2352 x 1568 pixels.
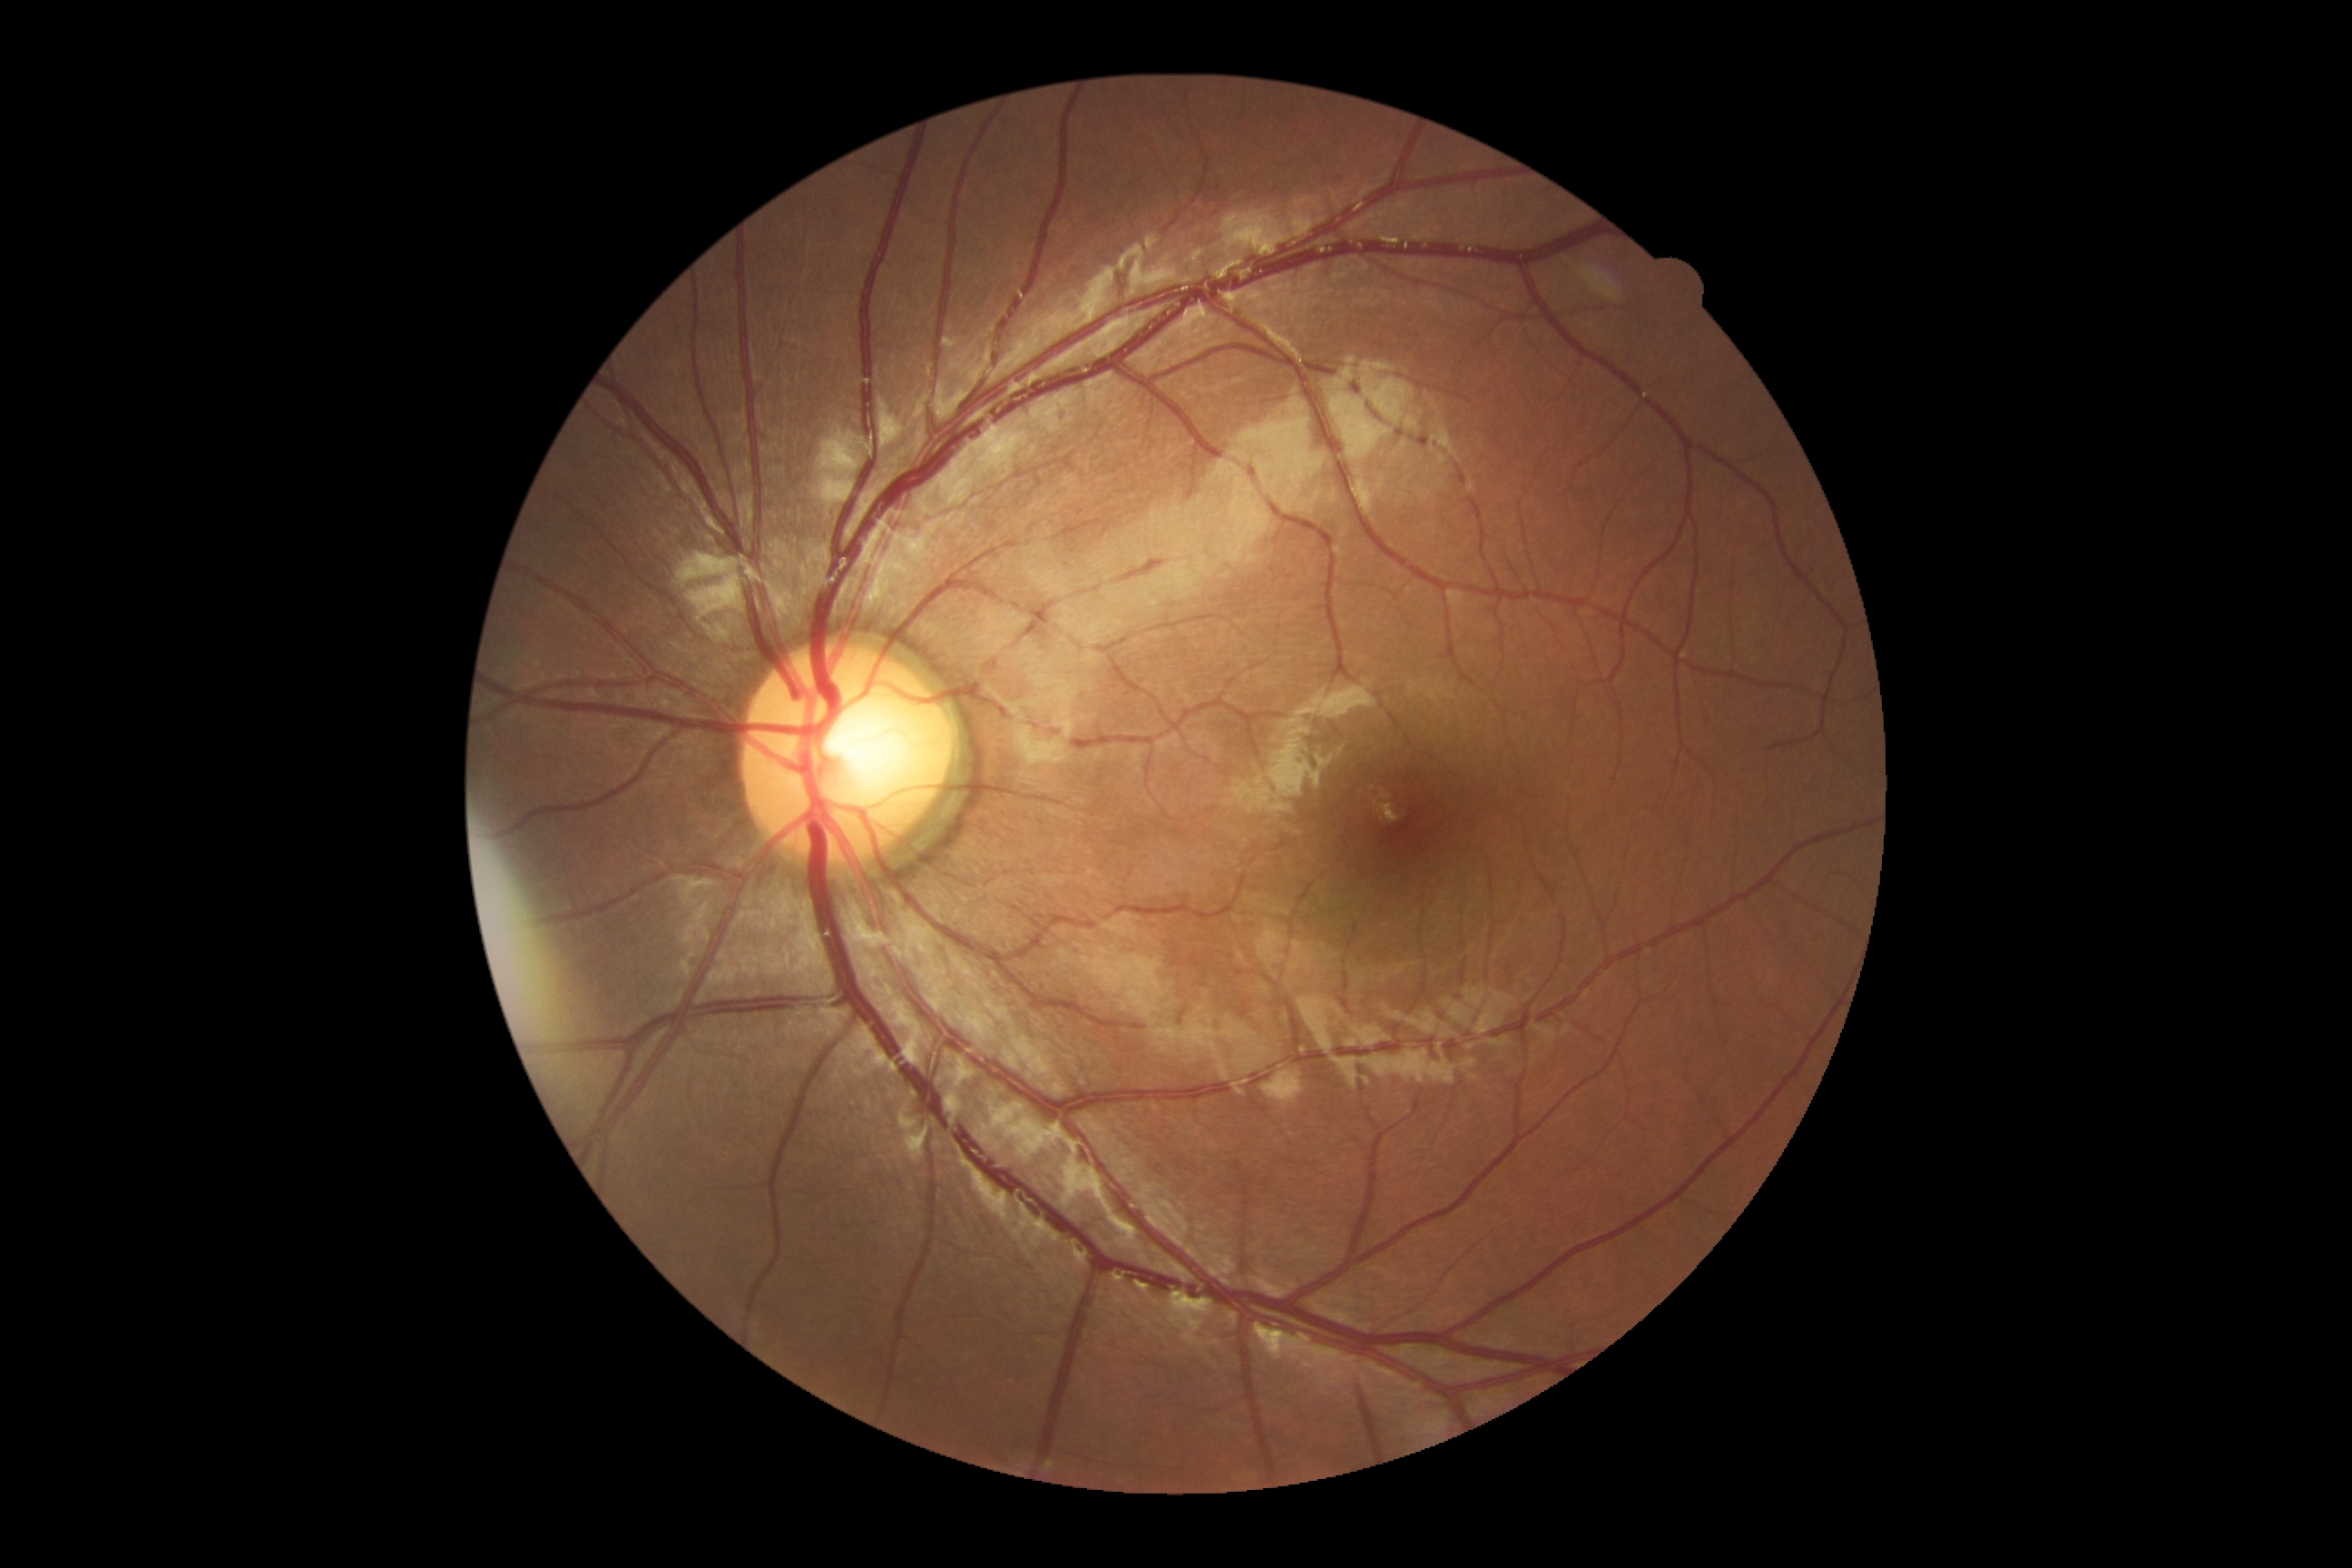
{
  "dr_grade": "grade 0 — no visible signs of diabetic retinopathy"
}